Retinal fundus photograph.
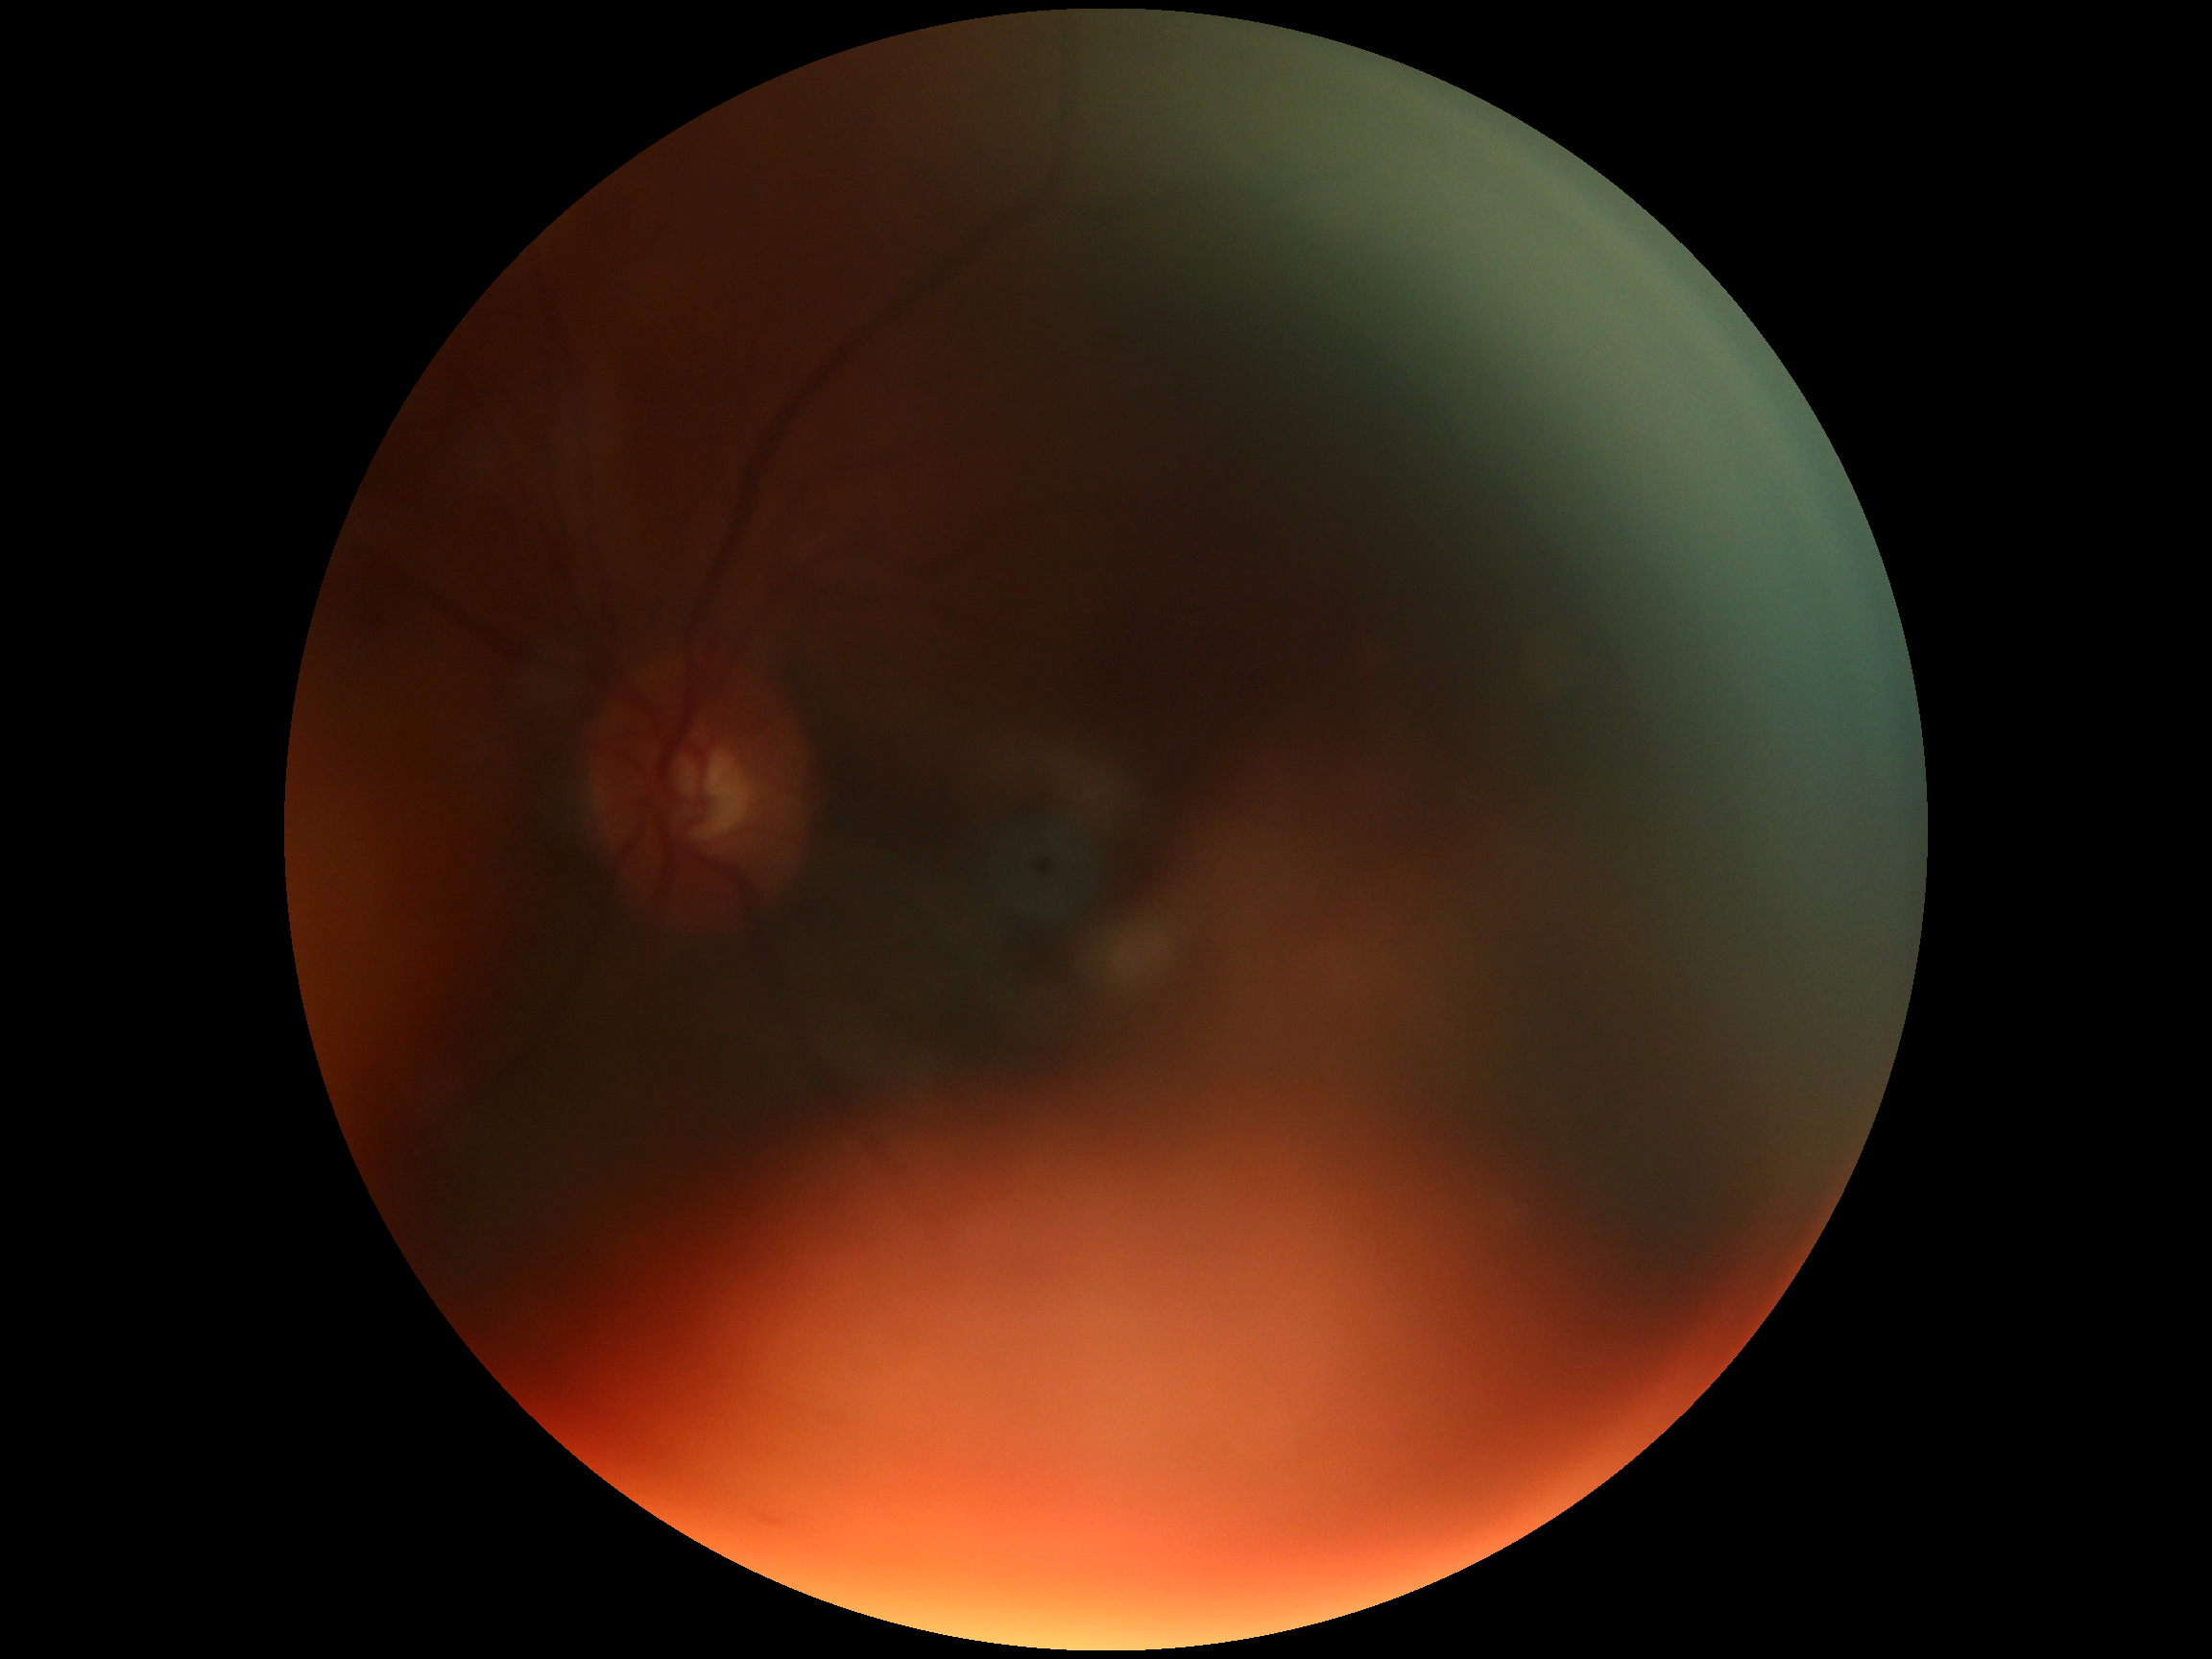 Quality too poor to assess for DR.
Diabetic retinopathy (DR): ungradable due to poor image quality.